Camera: Nidek AFC-330
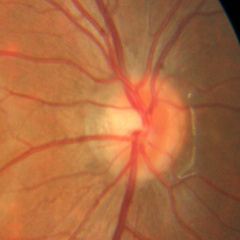 There is evidence of no signs of glaucoma.